Retinal fundus photograph · 1380x1382px:
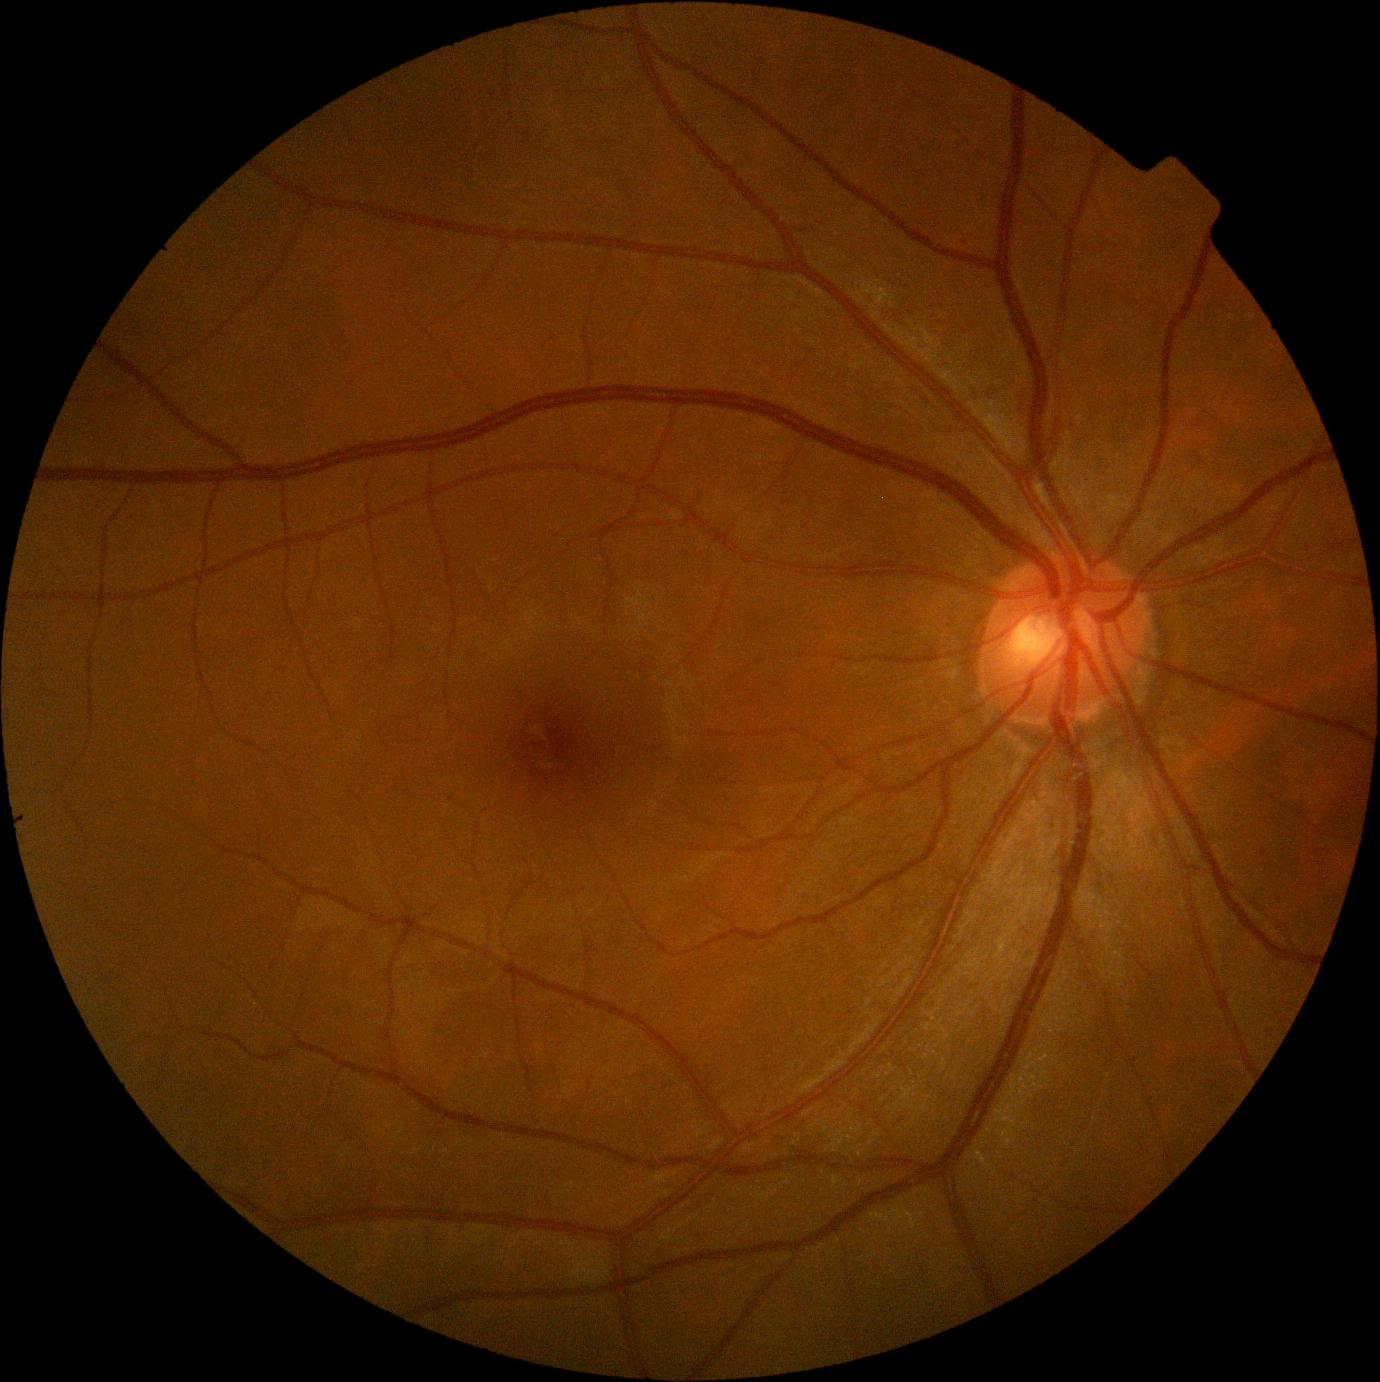

Diabetic retinopathy (DR): no apparent retinopathy (grade 0). No signs of diabetic retinopathy.